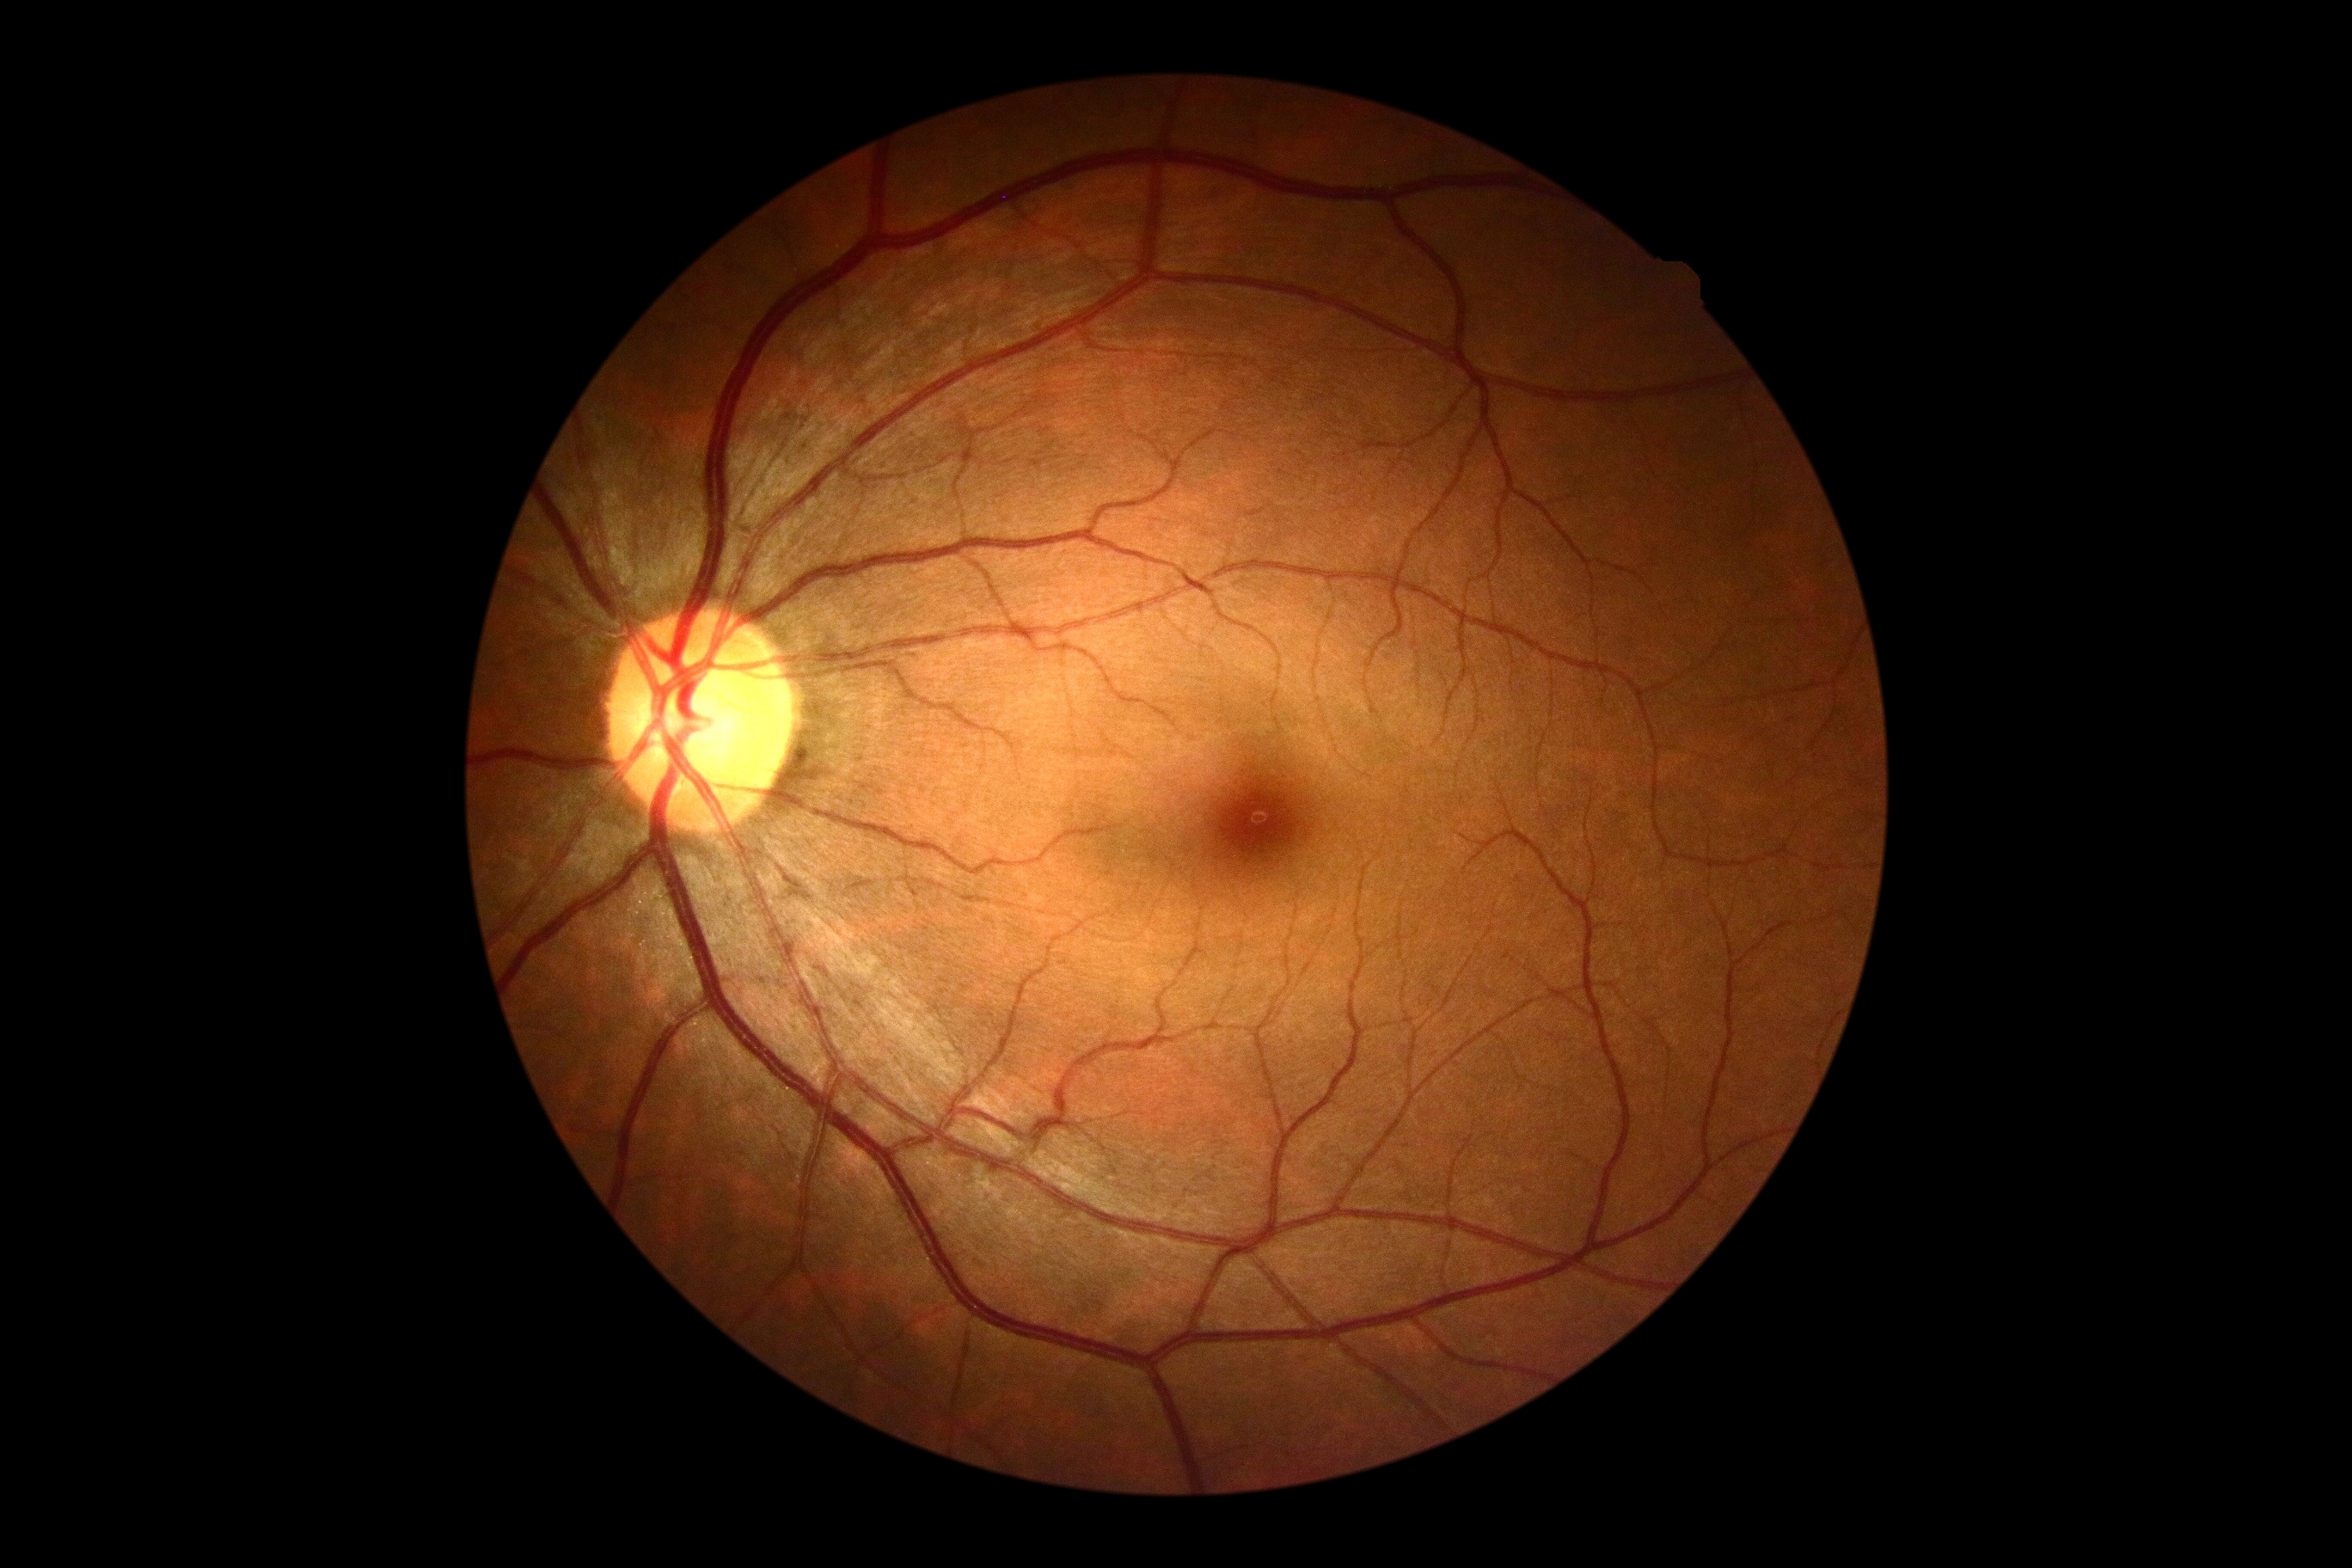
{
  "dr_grade": "no apparent retinopathy (grade 0) — no visible signs of diabetic retinopathy"
}